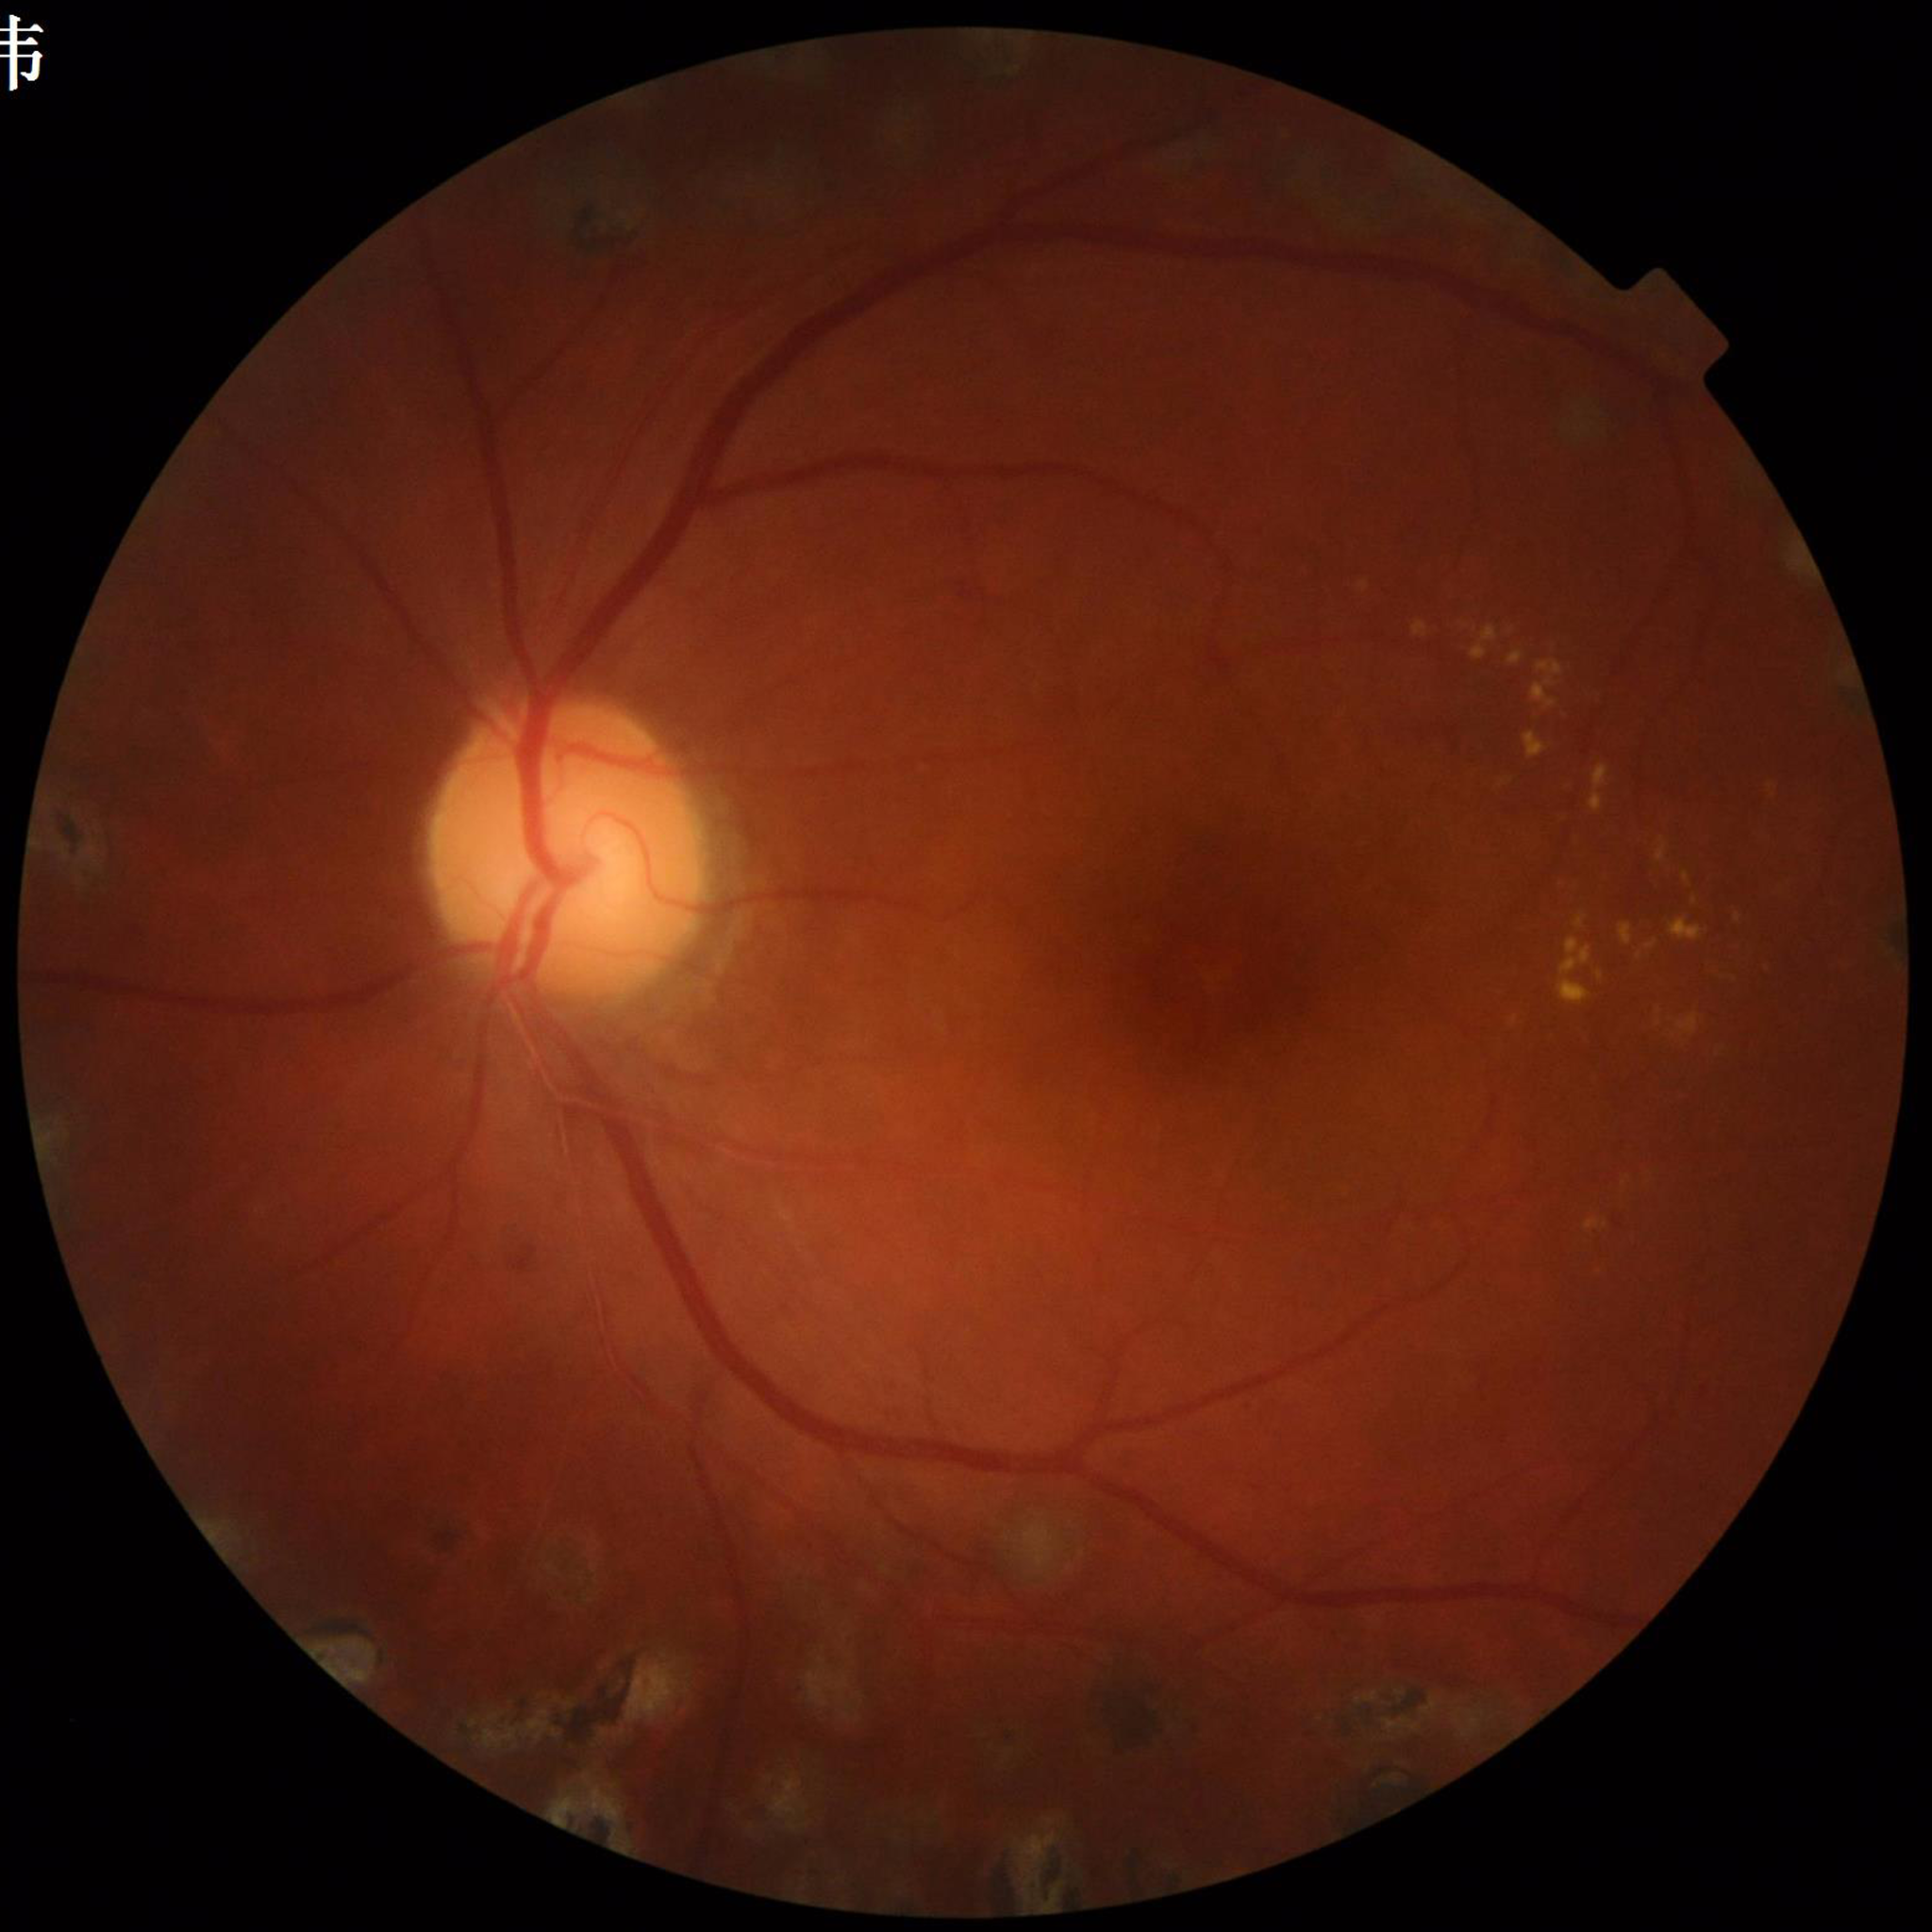 Clinical diagnosis: diabetic retinopathy (DR)